Retinal fundus photograph · acquired with a NIDEK AFC-230 · 848x848px · nonmydriatic fundus photograph: 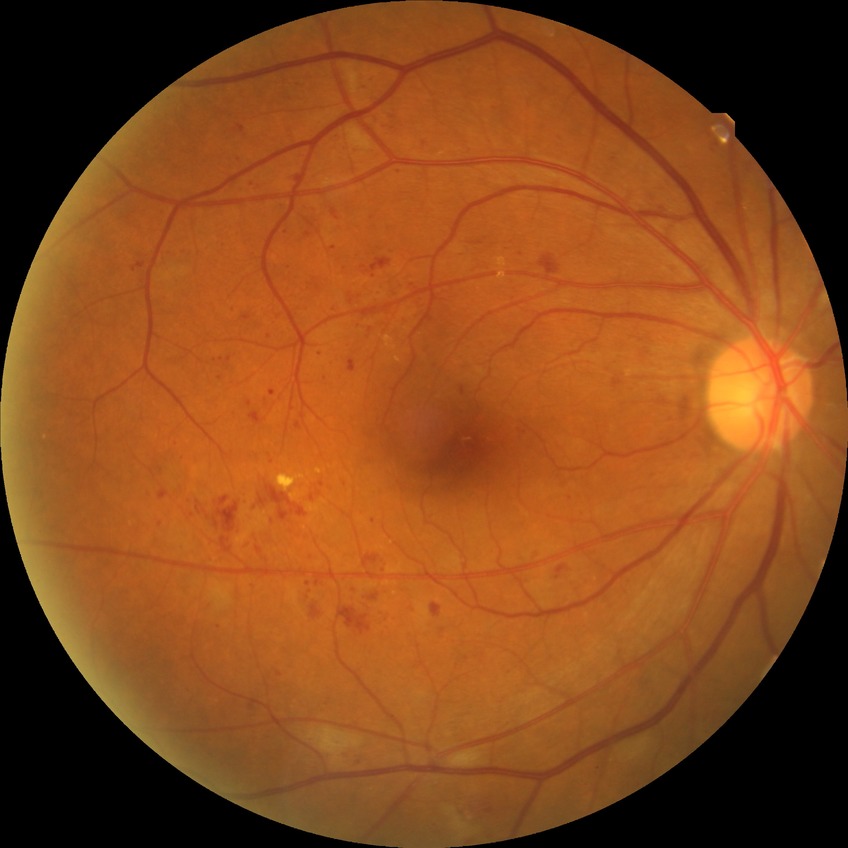 diabetic retinopathy (DR): pre-proliferative diabetic retinopathy (PPDR).